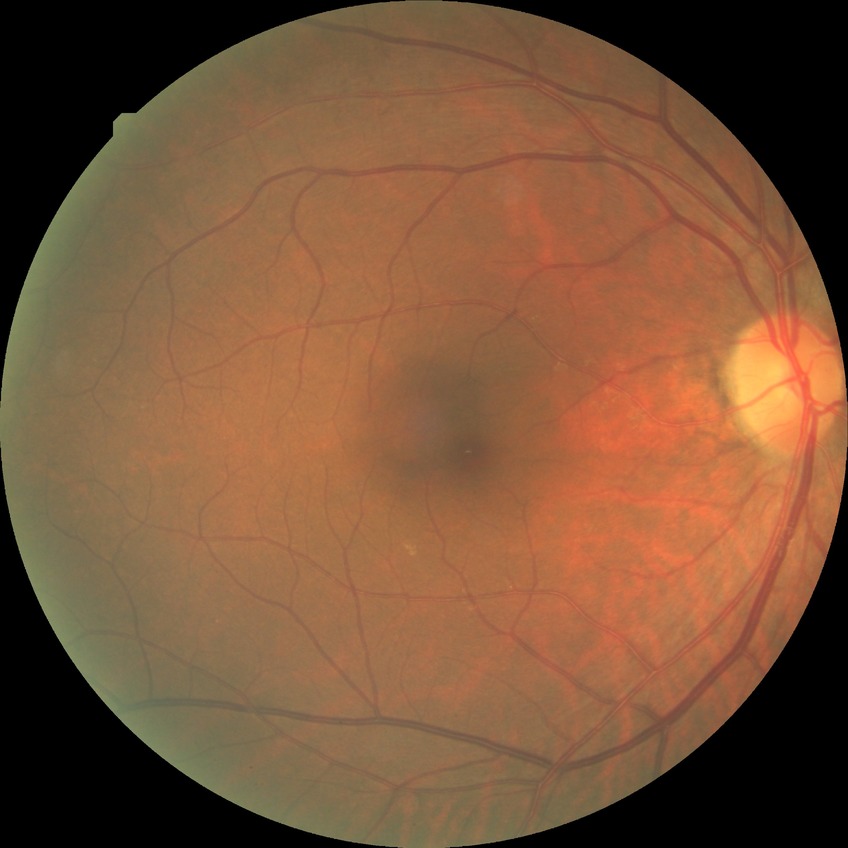
Diabetic retinopathy (DR): no diabetic retinopathy (NDR).